Wide-field fundus image from infant ROP screening — 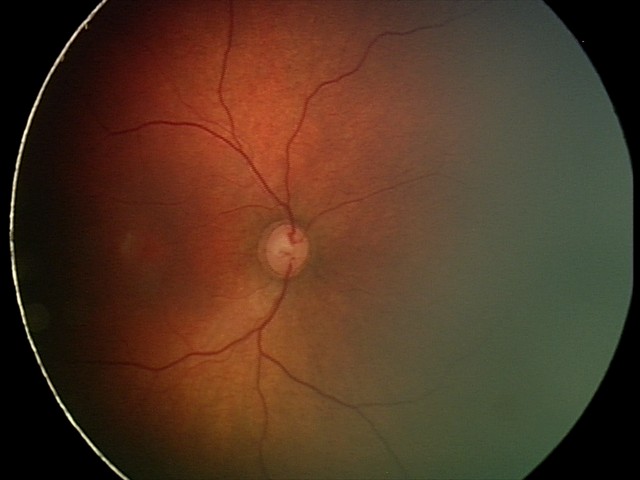
Physiological retinal appearance for postconceptual age.